Nonmydriatic fundus photograph · NIDEK AFC-230.
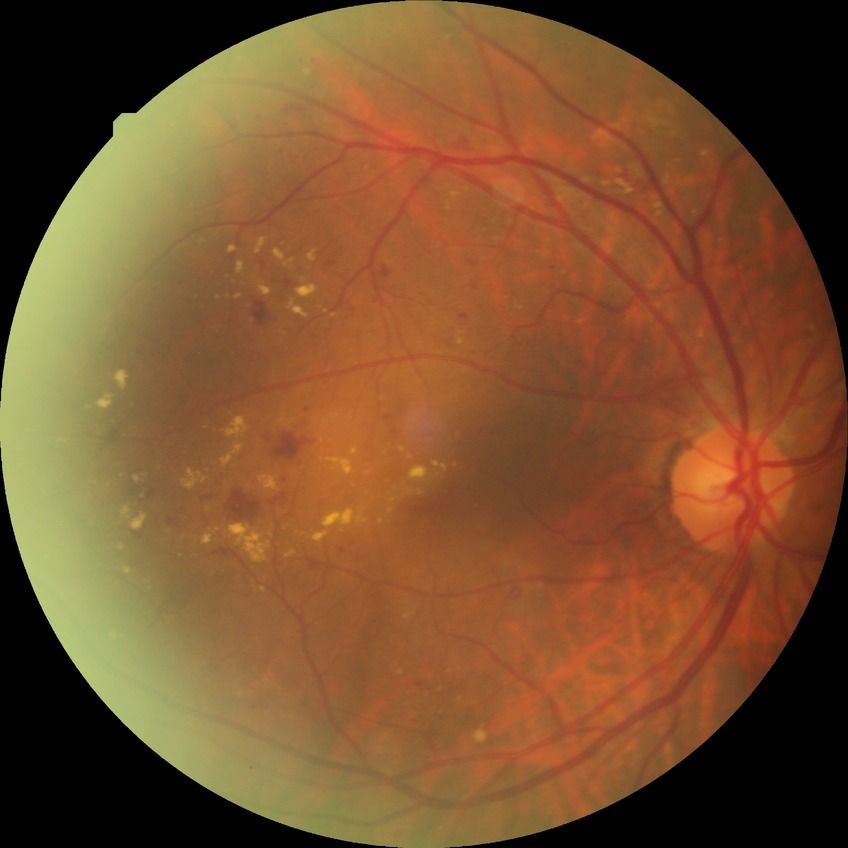
Retinopathy grade: pre-proliferative diabetic retinopathy.